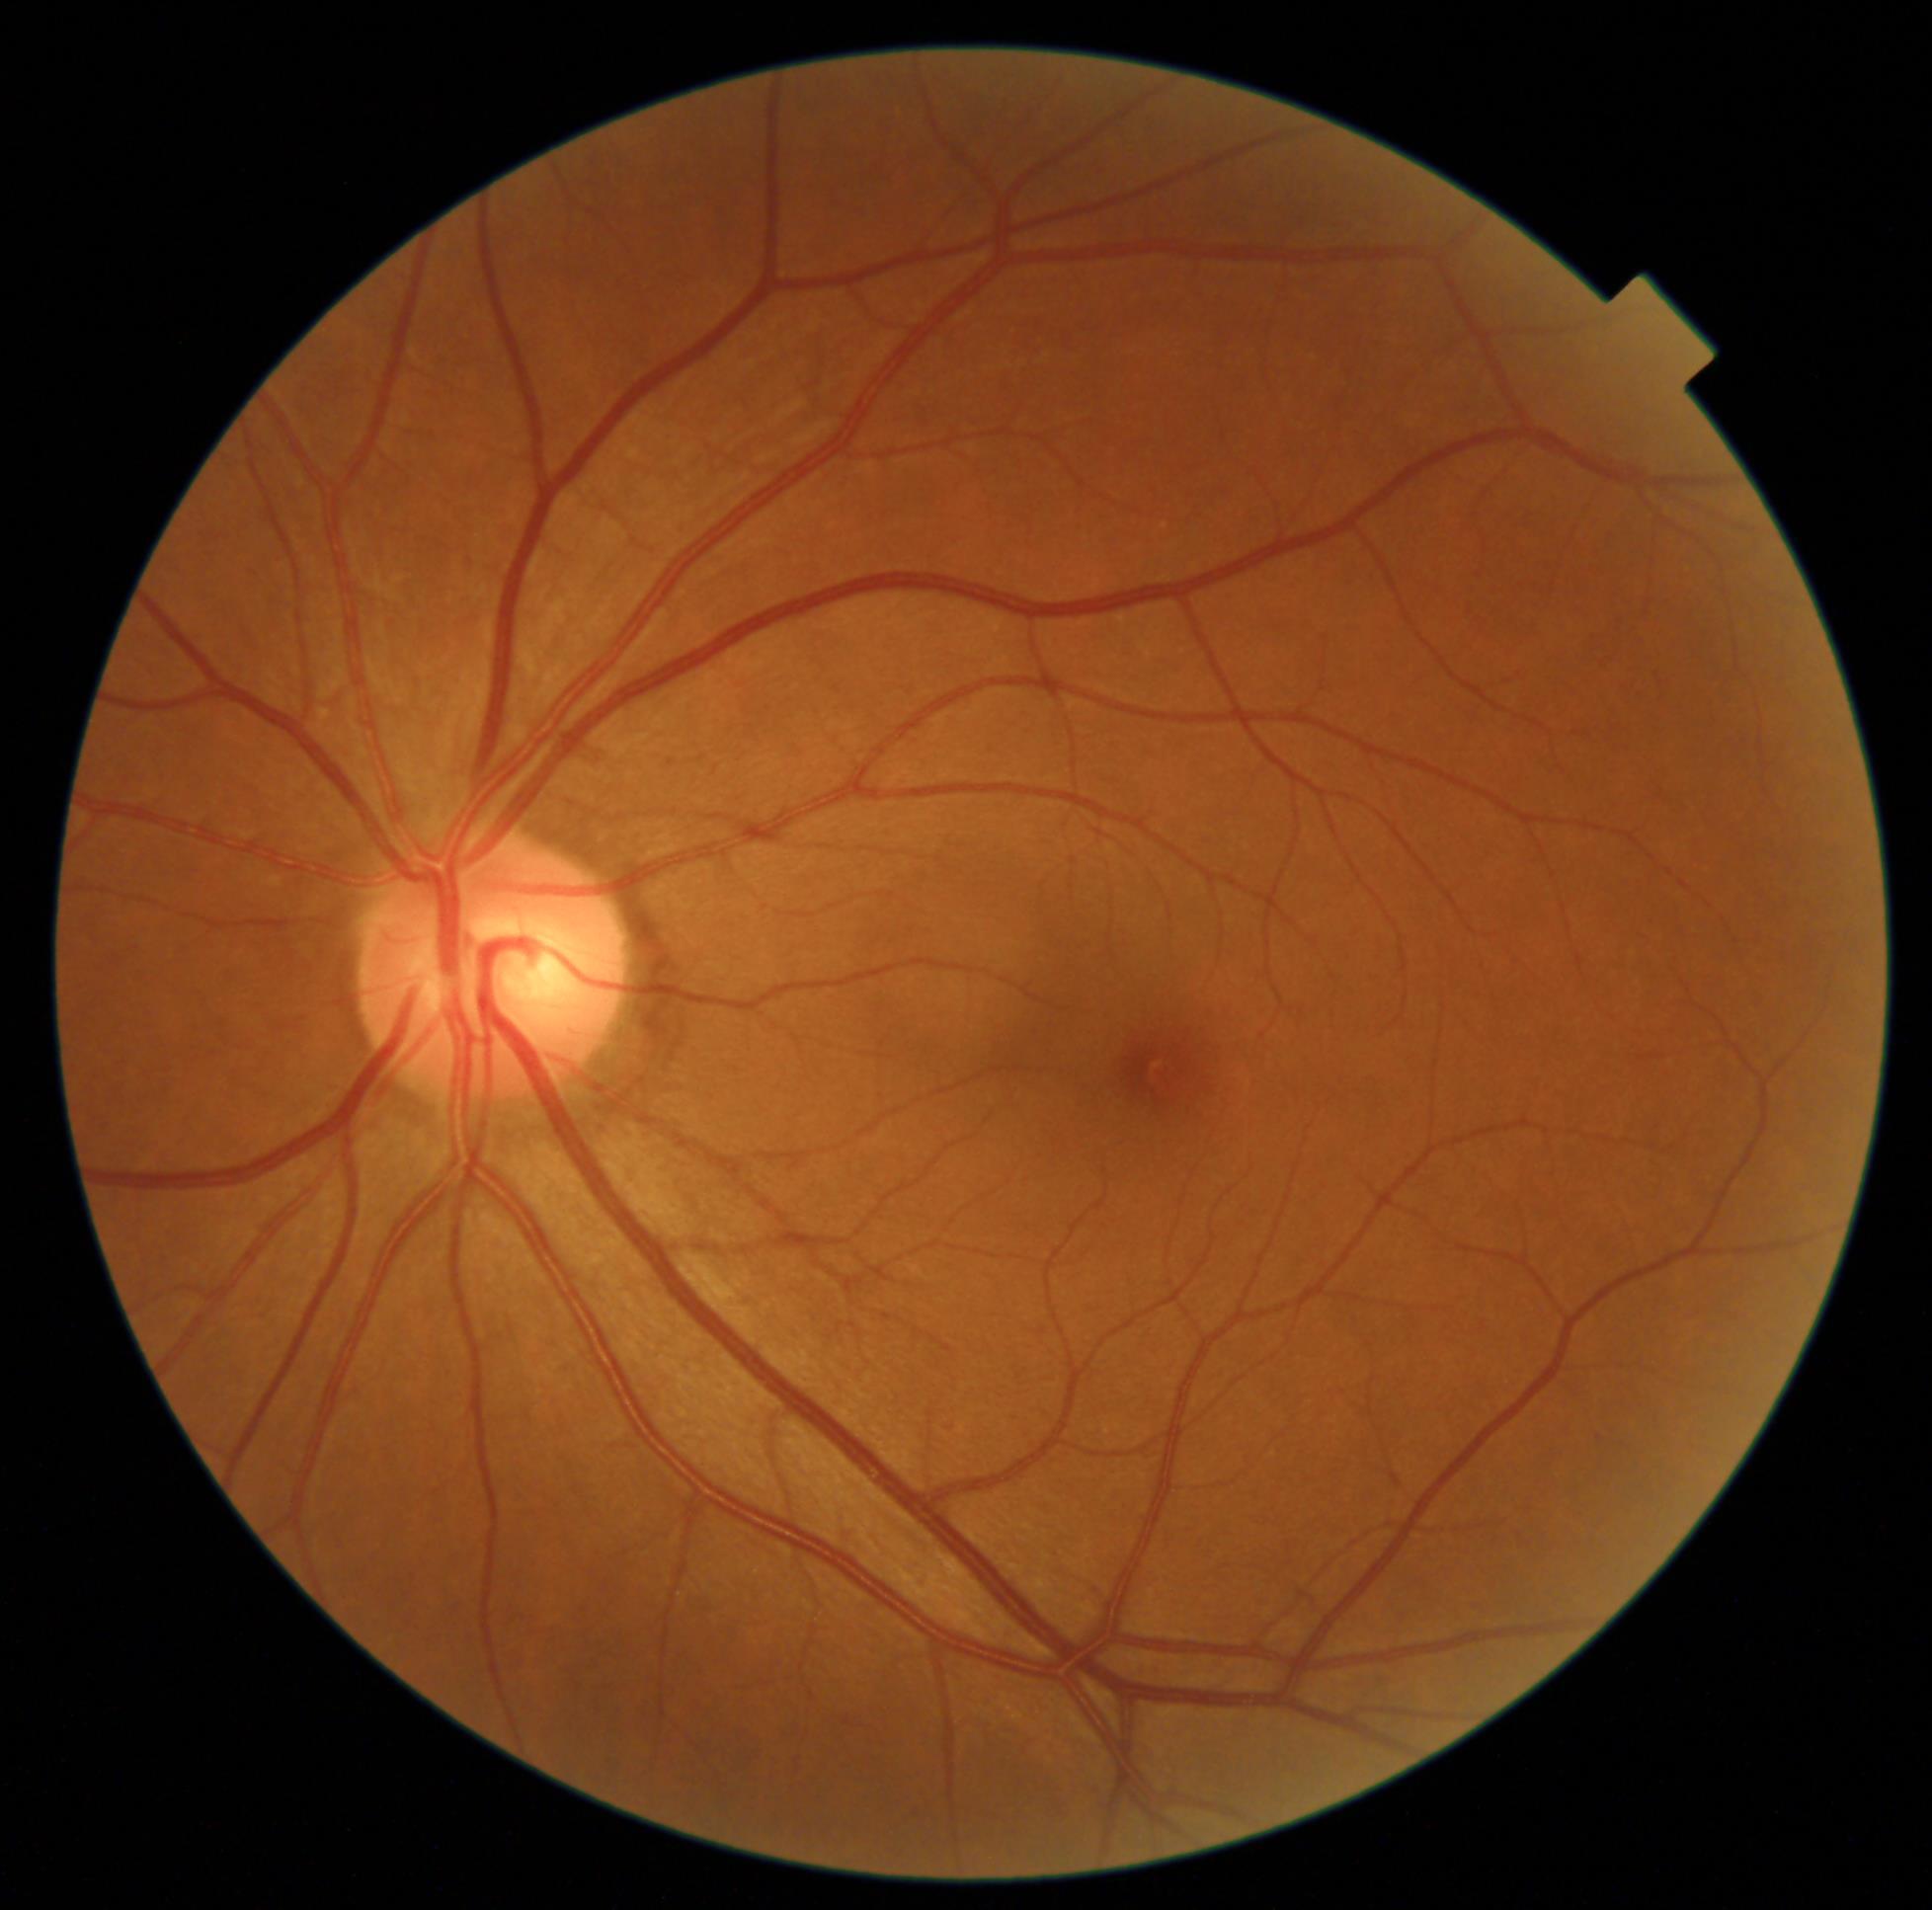 Diabetic retinopathy grade is 0/4.
No DR findings.